2352 by 1568 pixels; CFP.
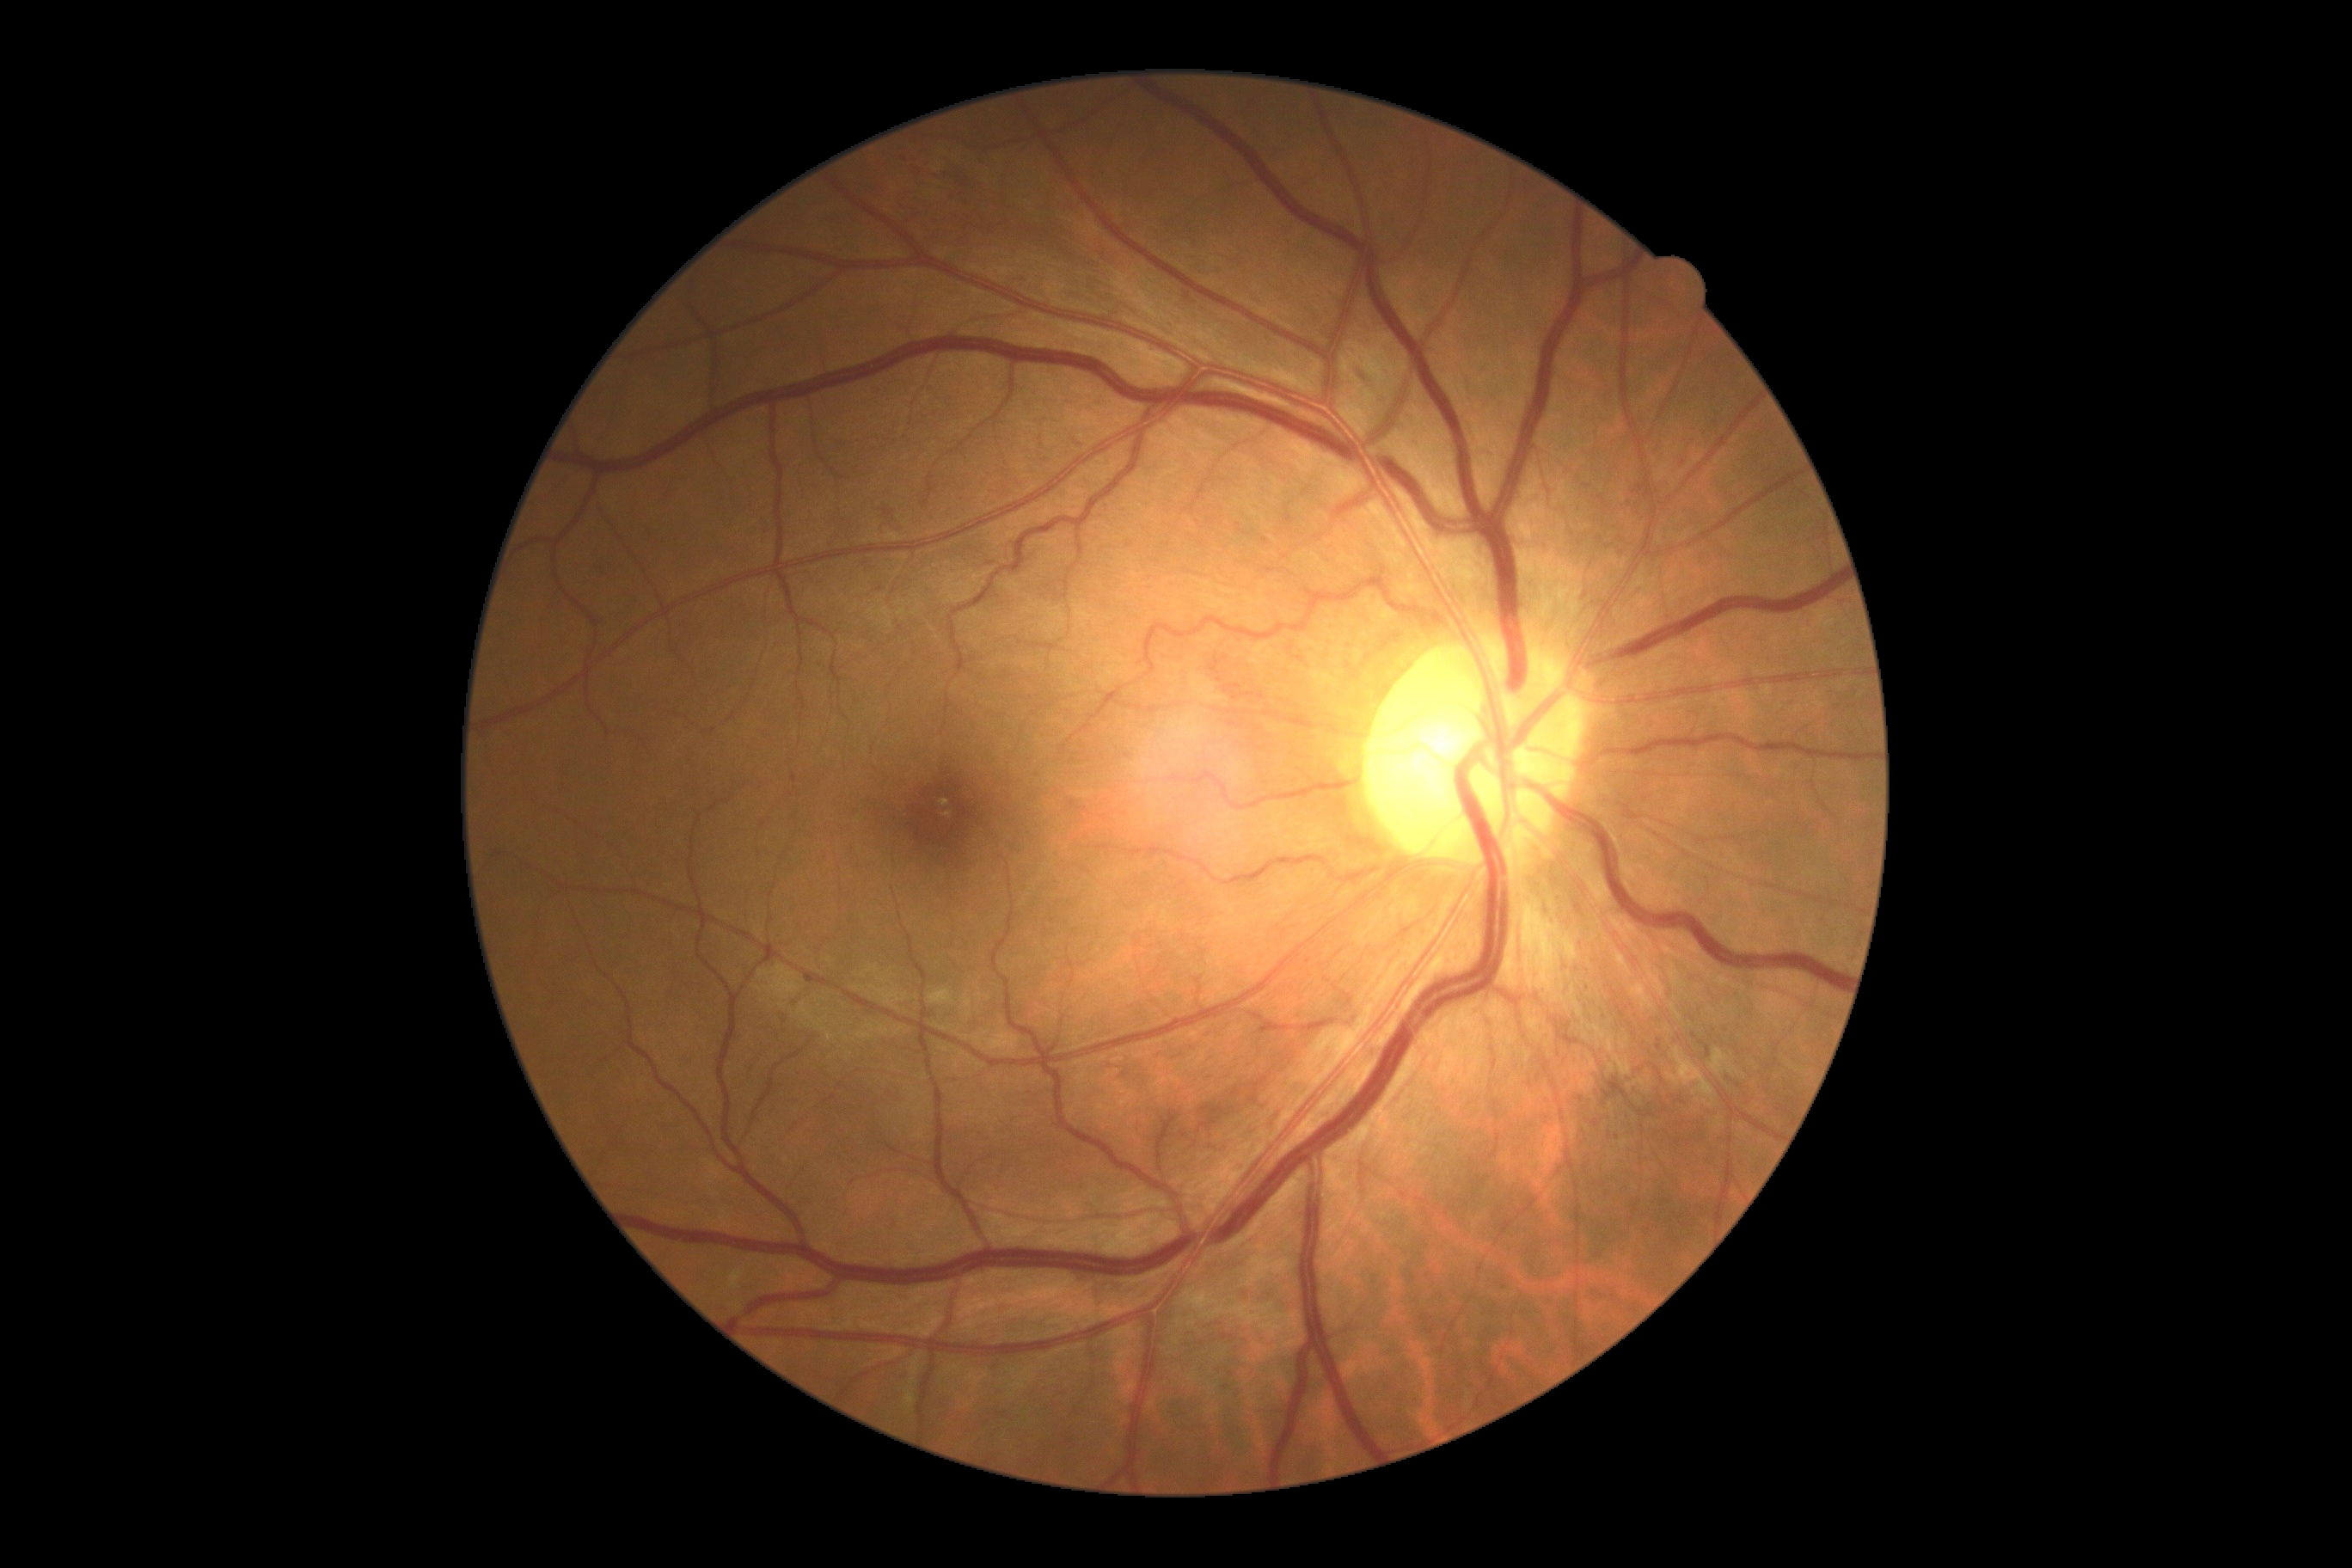
retinopathy = grade 3 (severe NPDR) — more than 20 intraretinal hemorrhages in each of 4 quadrants, definite venous beading in 2 or more quadrants, or prominent intraretinal microvascular abnormalities in 1 or more quadrants, with no signs of proliferative retinopathy, DR class = non-proliferative diabetic retinopathy.